CFP. Nonmydriatic fundus photograph:
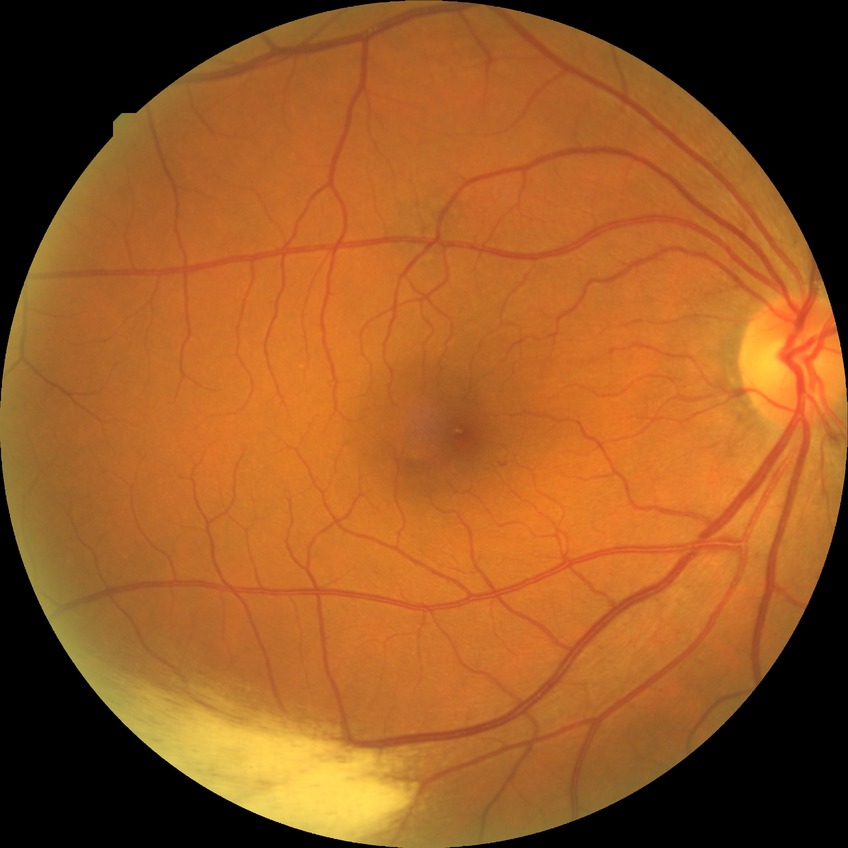 DR grade: SDR